Color fundus image — 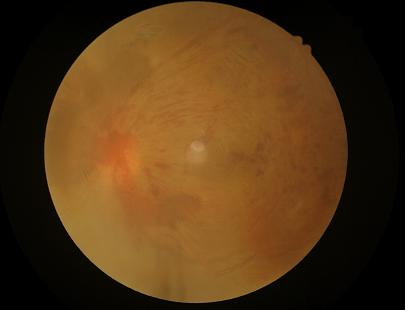 Overall = poor, ungradable; Illumination = uneven illumination or color cast; Clarity = reduced sharpness with visible blur; Contrast = poor dynamic range.